Retinal fundus photograph — 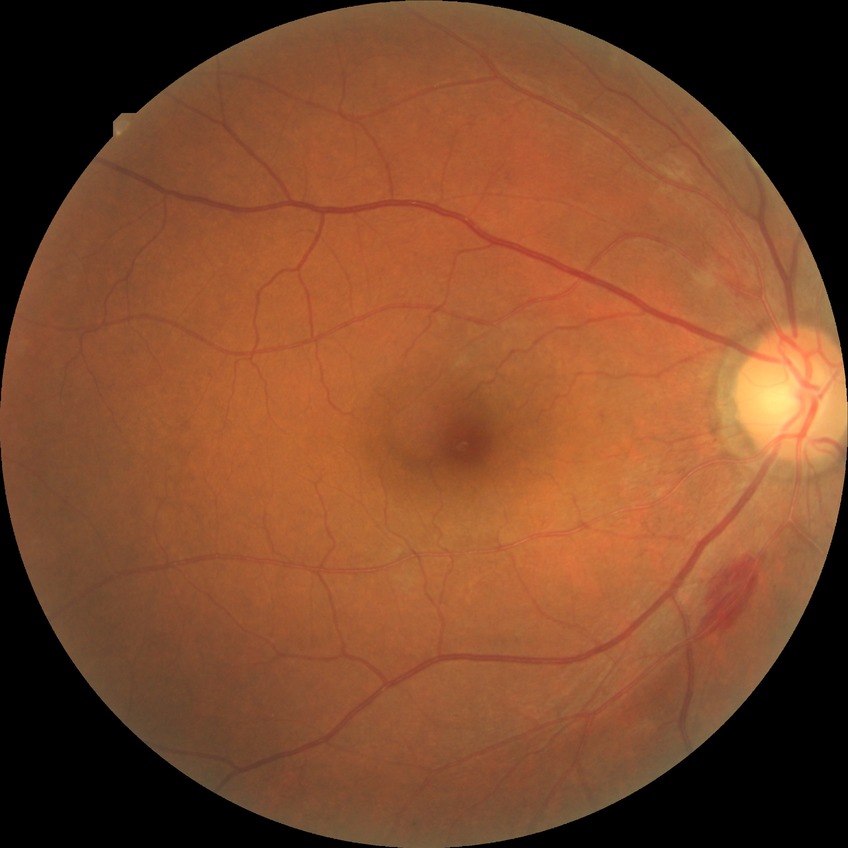
Diabetic retinopathy (DR) is PPDR (pre-proliferative diabetic retinopathy).